Diabetic retinopathy graded by the modified Davis classification
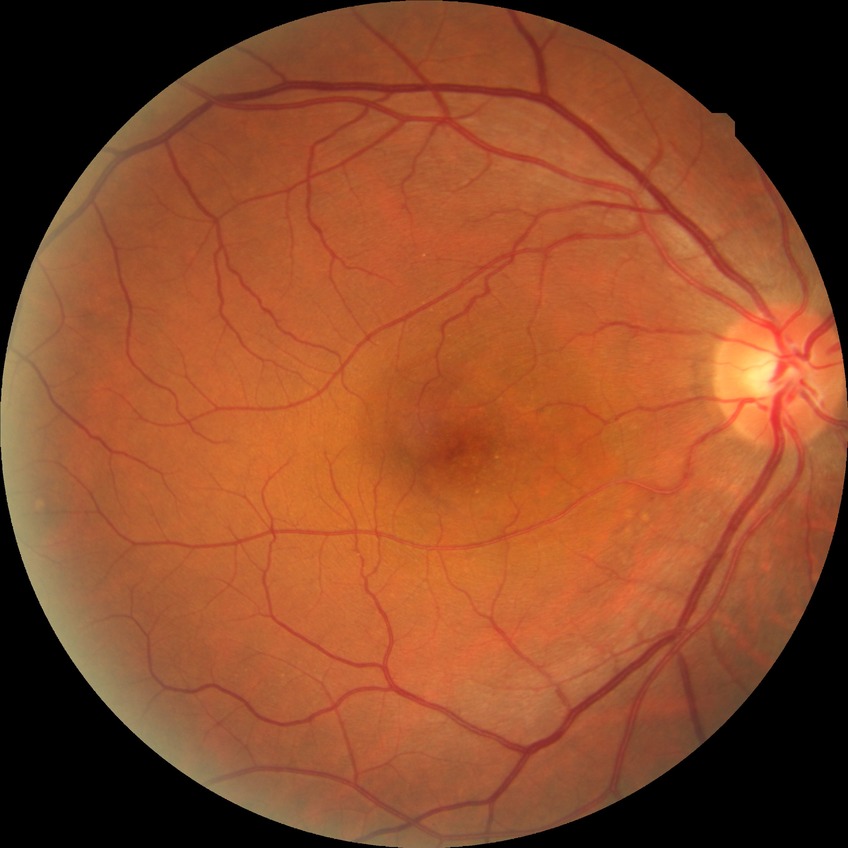 Diabetic retinopathy grade is no diabetic retinopathy.